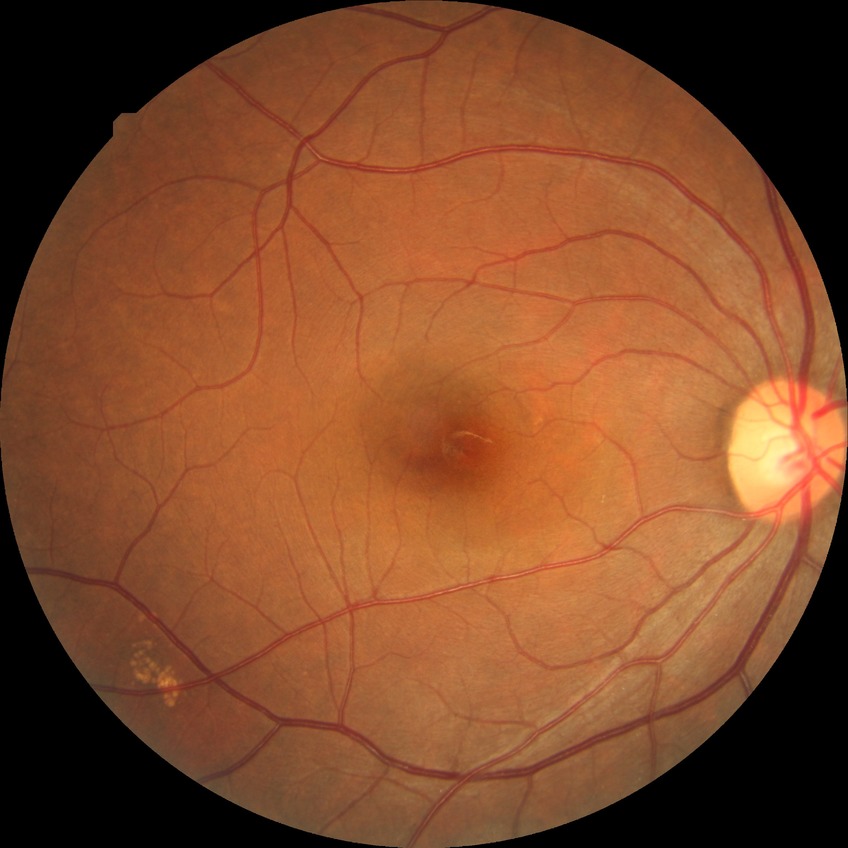 Diabetic retinopathy grade: no diabetic retinopathy.